Fundus photo
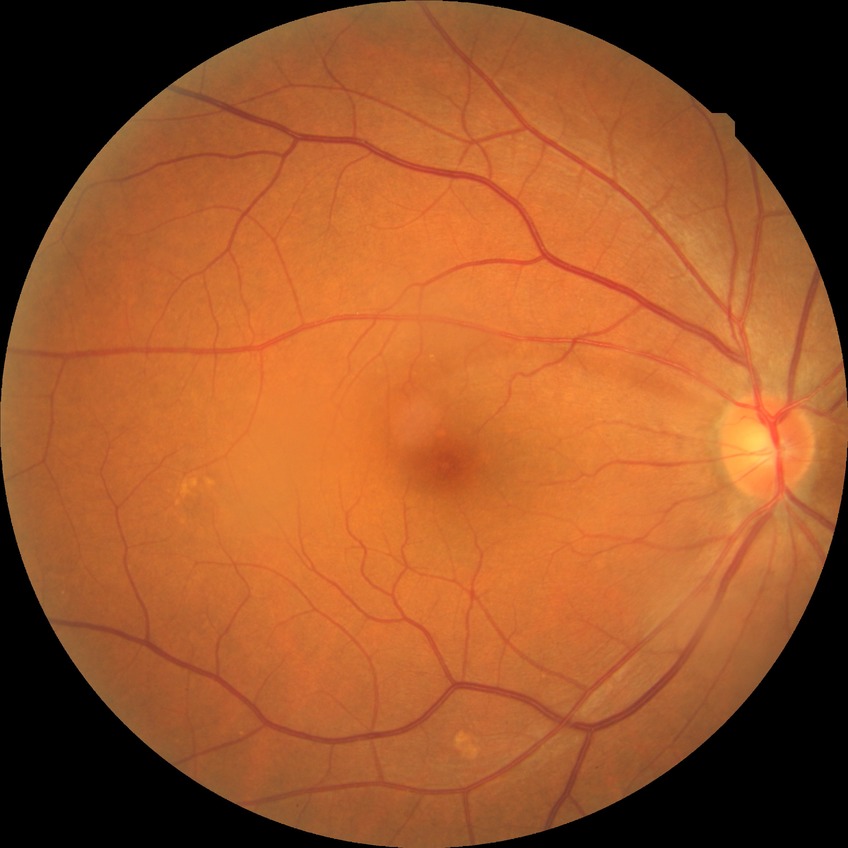

Diabetic retinopathy (DR) is no diabetic retinopathy (NDR).